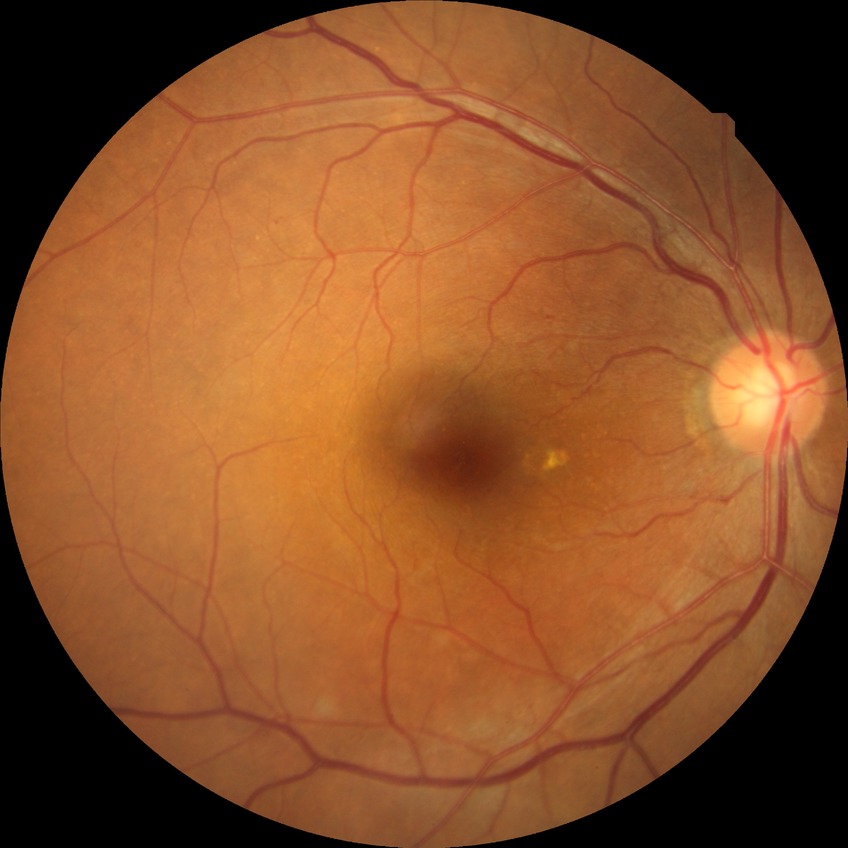

  davis_grade: simple diabetic retinopathy
  proliferative_class: non-proliferative diabetic retinopathy